FOV: 45 degrees, diabetic retinopathy graded by the modified Davis classification, acquired with a NIDEK AFC-230.
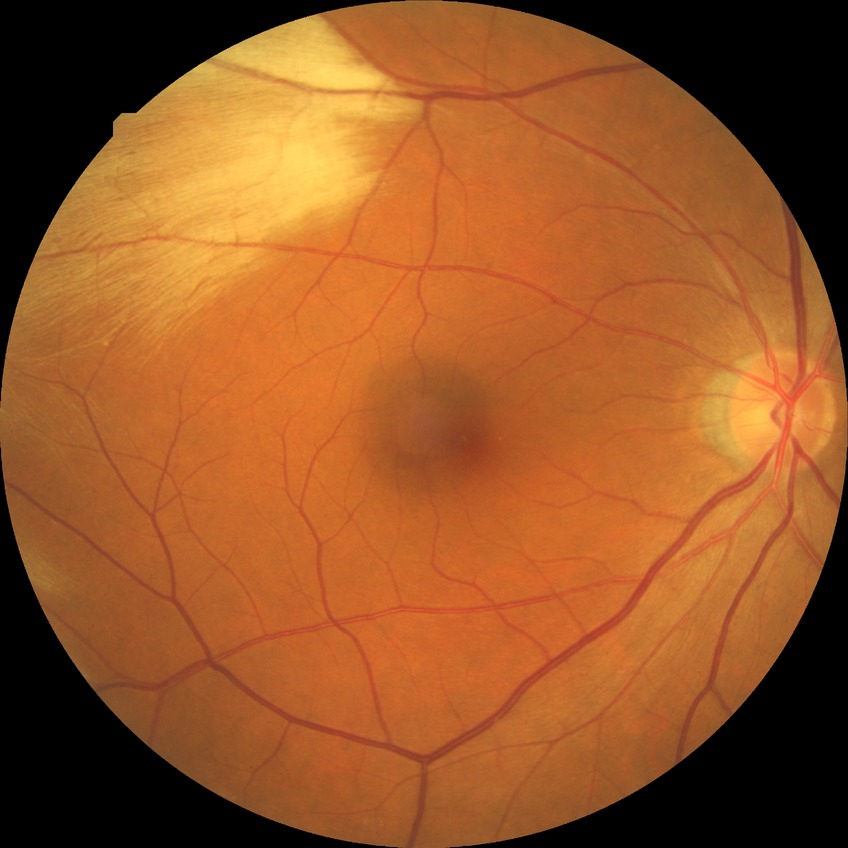 * diabetic retinopathy (DR): SDR (simple diabetic retinopathy)